Retinal fundus photograph; 1932x1910; 45° field of view: 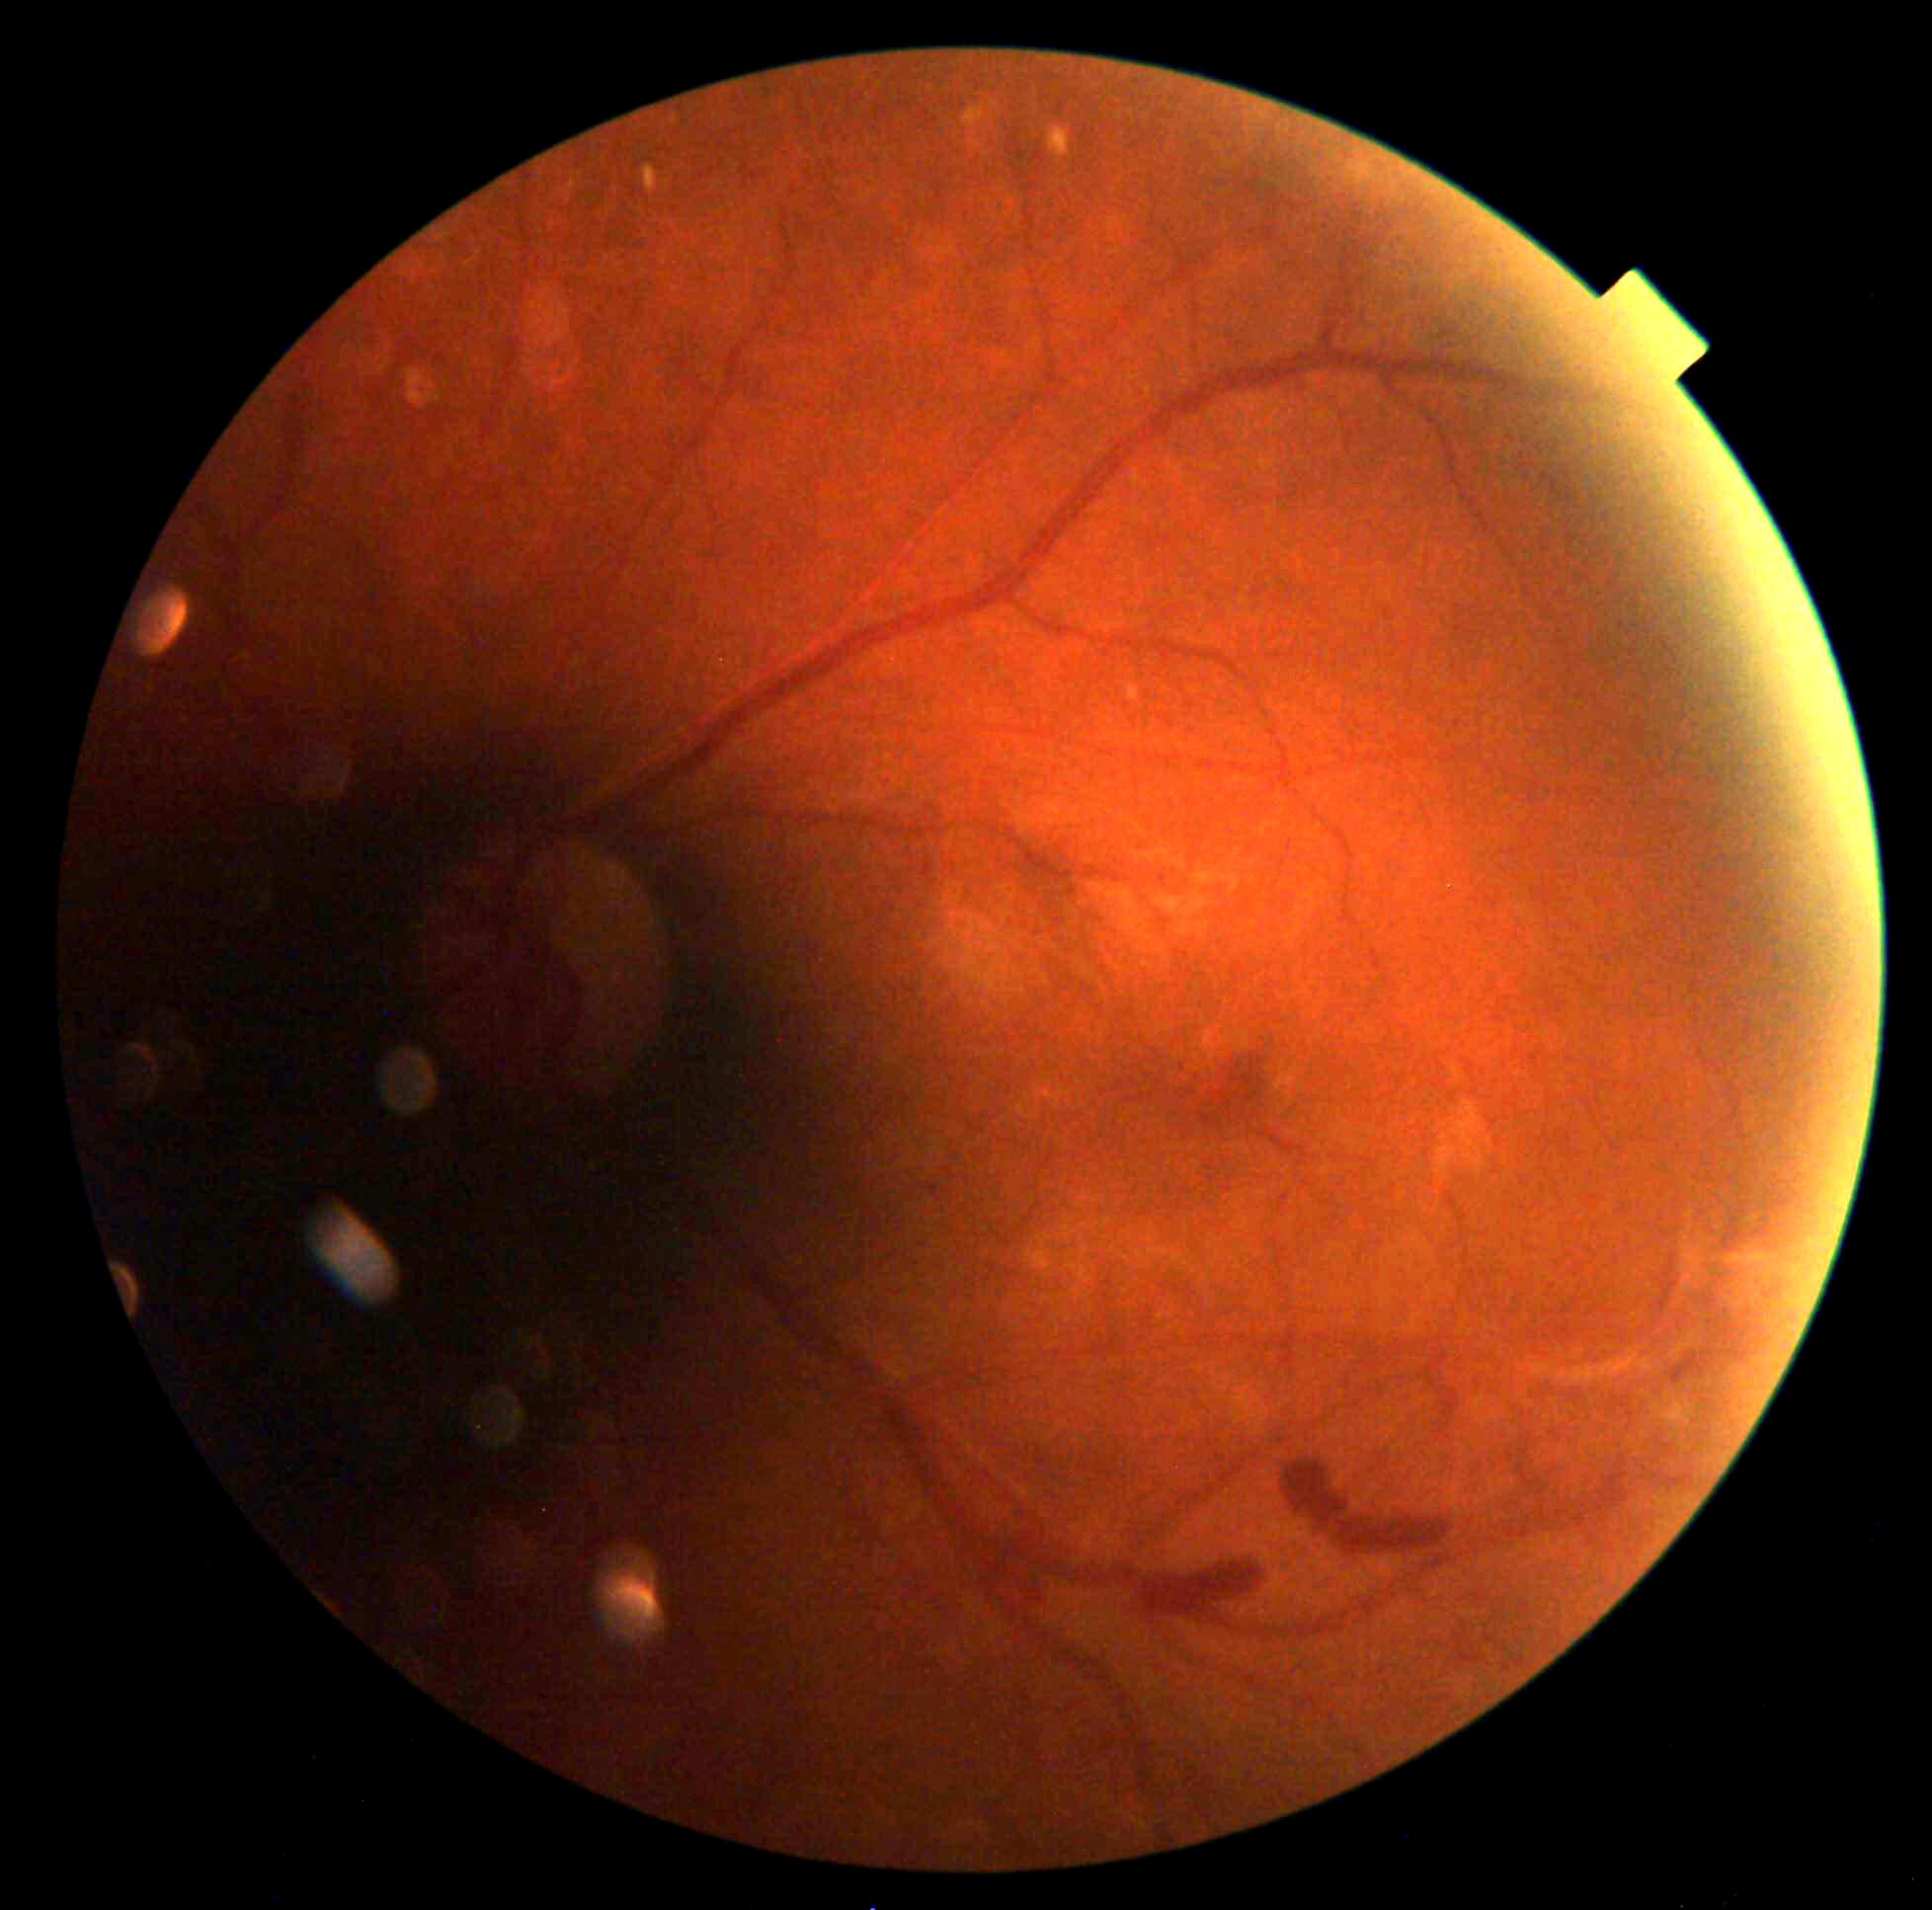

Annotations:
– retinopathy — grade 2